1659x2212px; retinal fundus photograph; Remidio smartphone fundus camera:
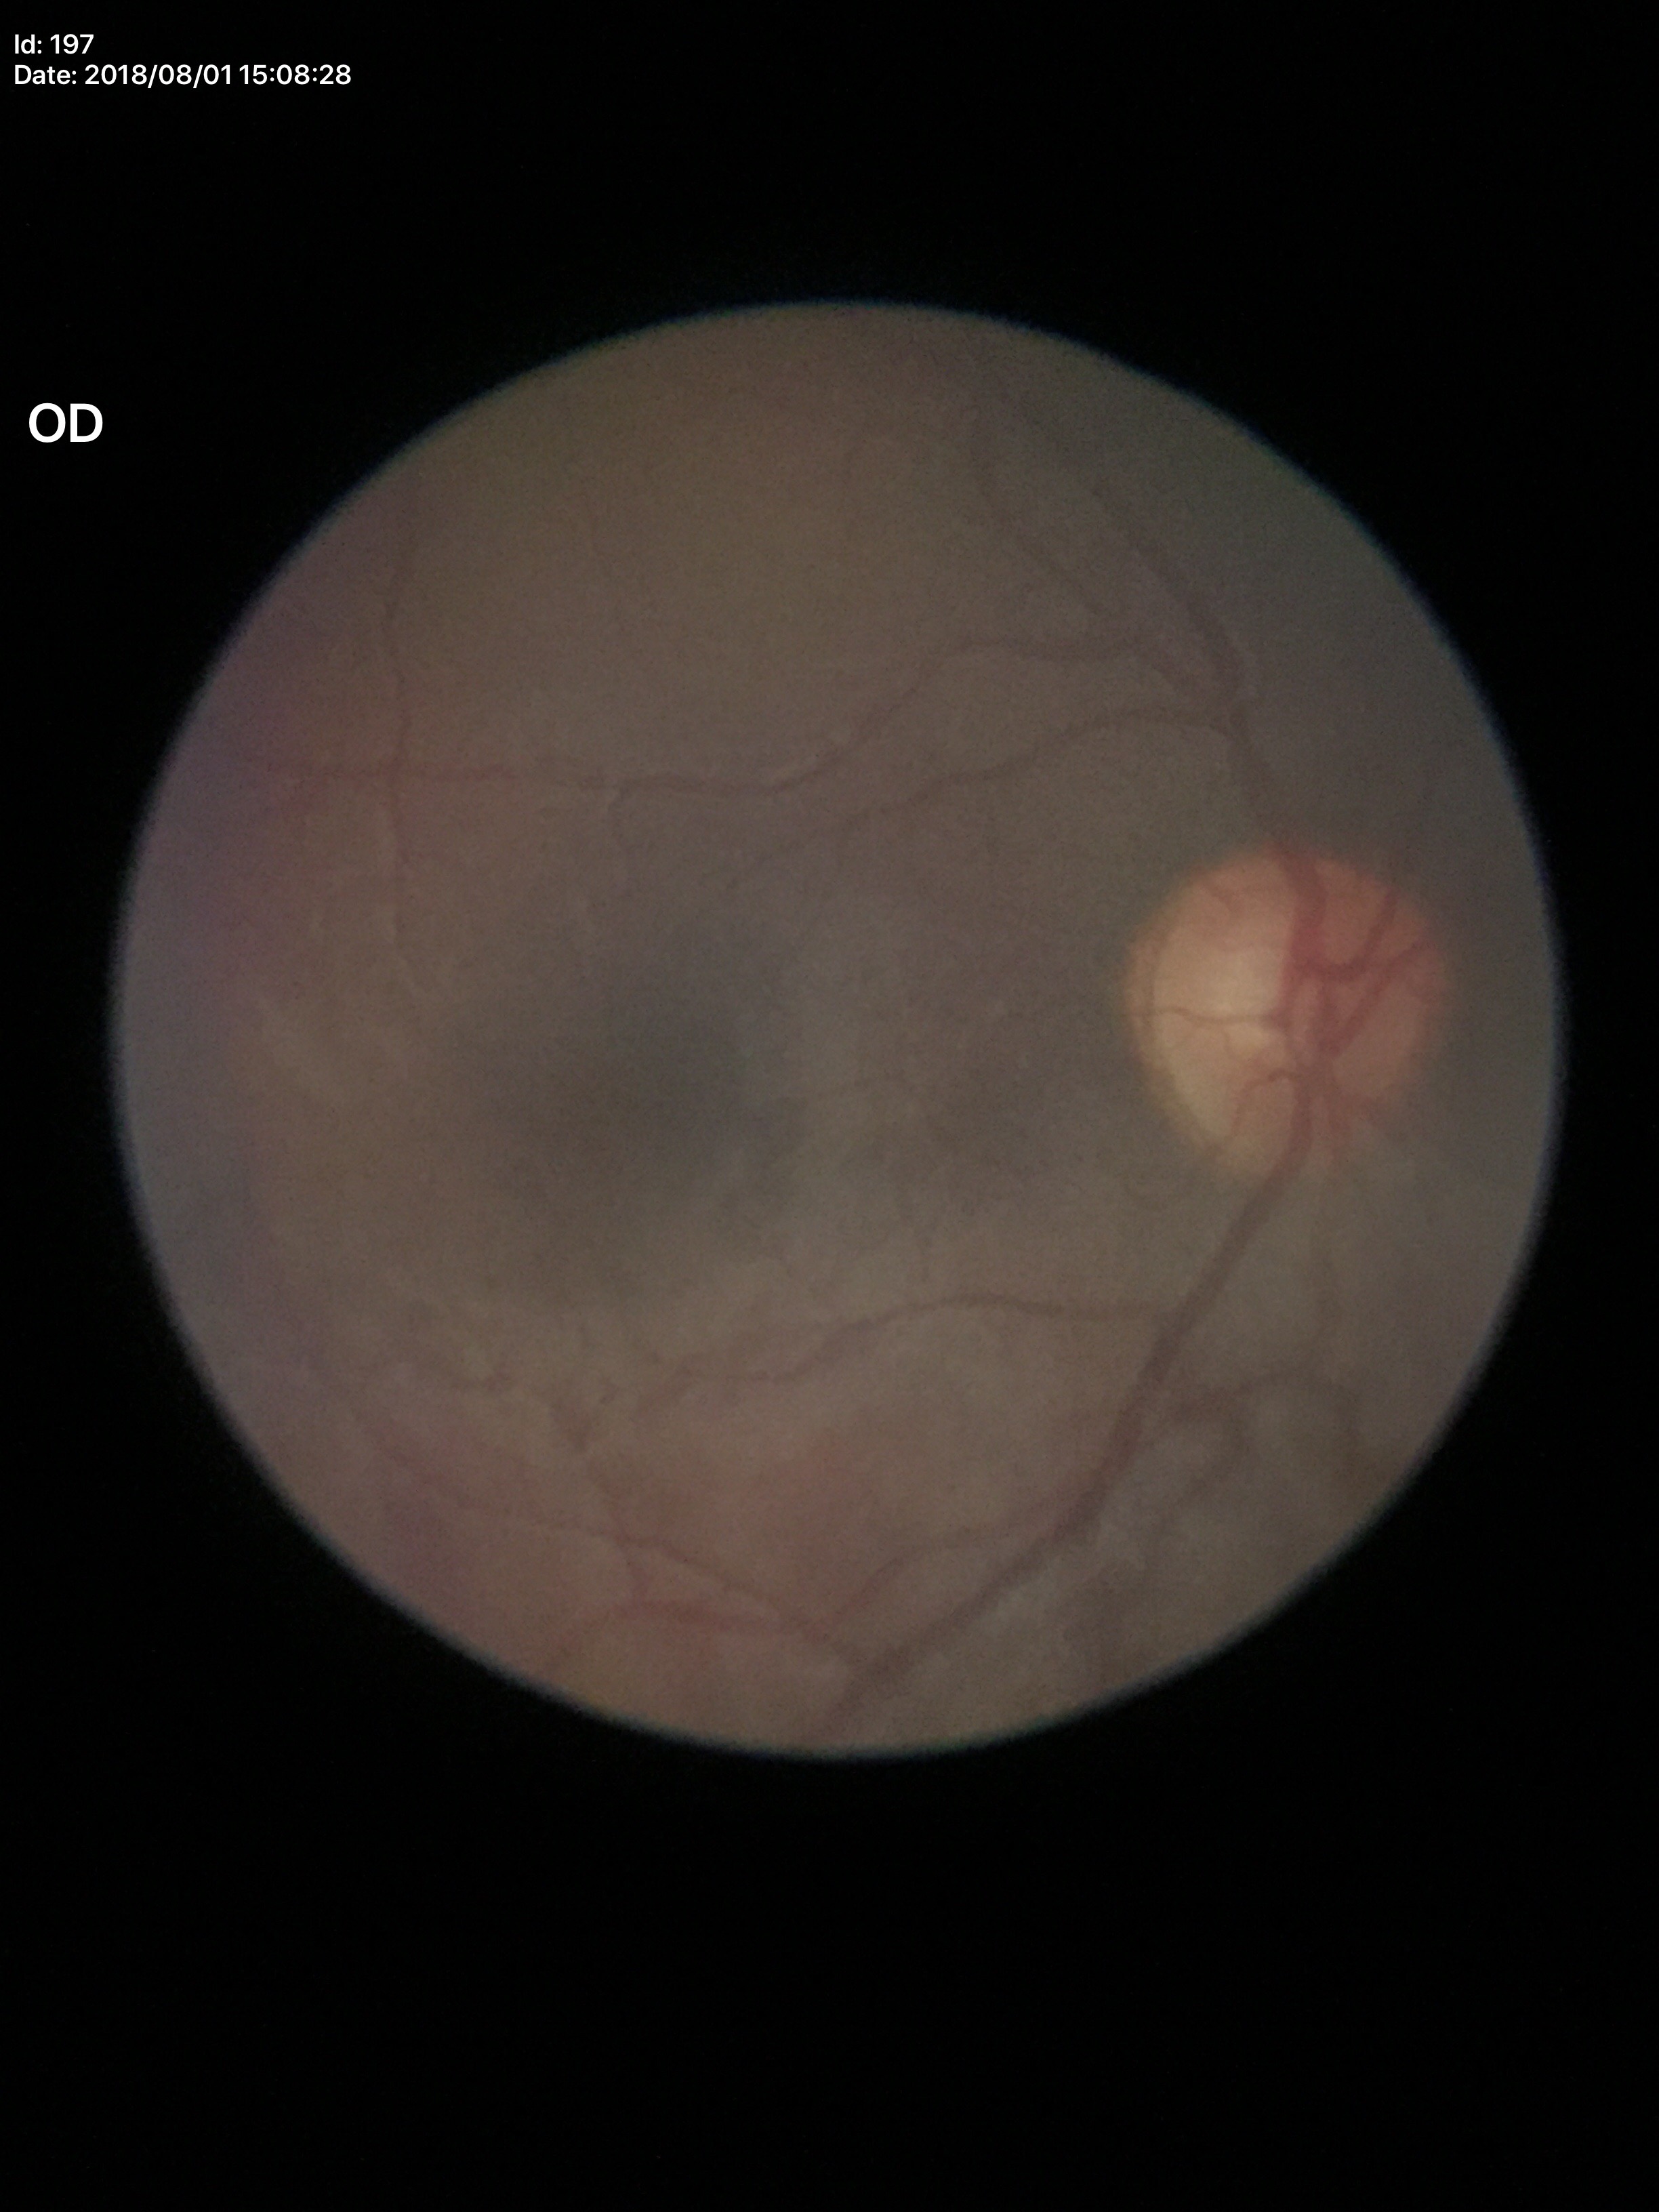

VCDR = 0.51, Glaucoma assessment = not suspect, ACDR = 0.29.